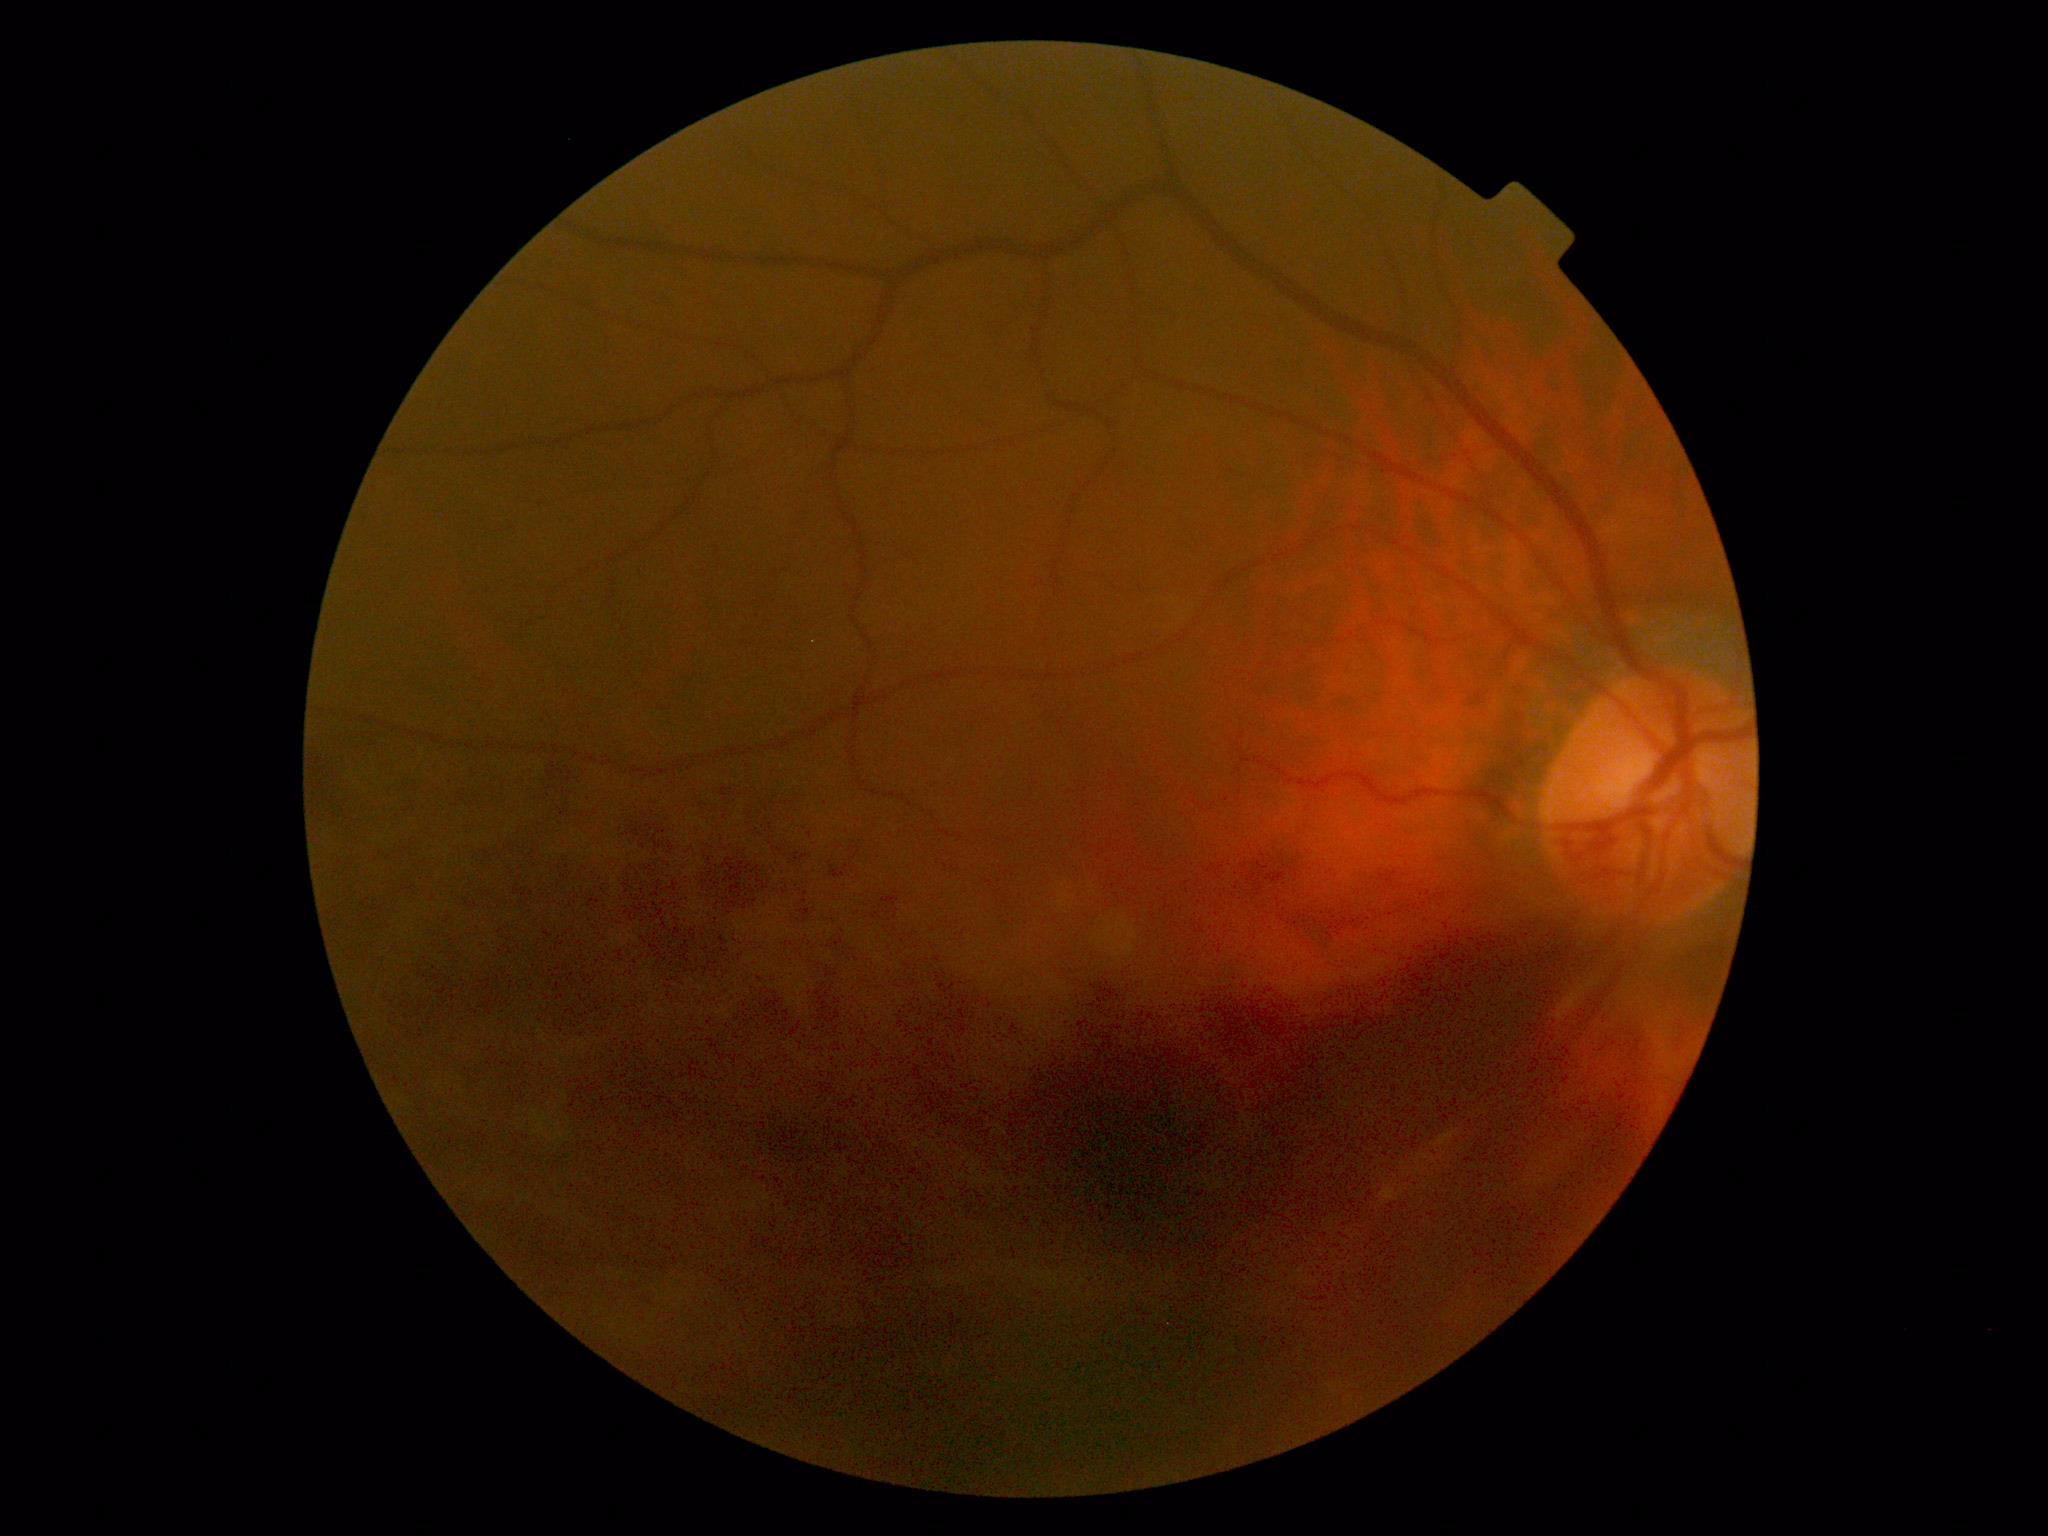
Disease class: proliferative diabetic retinopathy. Diabetic retinopathy grade: 4 (PDR).